Posterior pole view, 2228 x 1652 pixels.
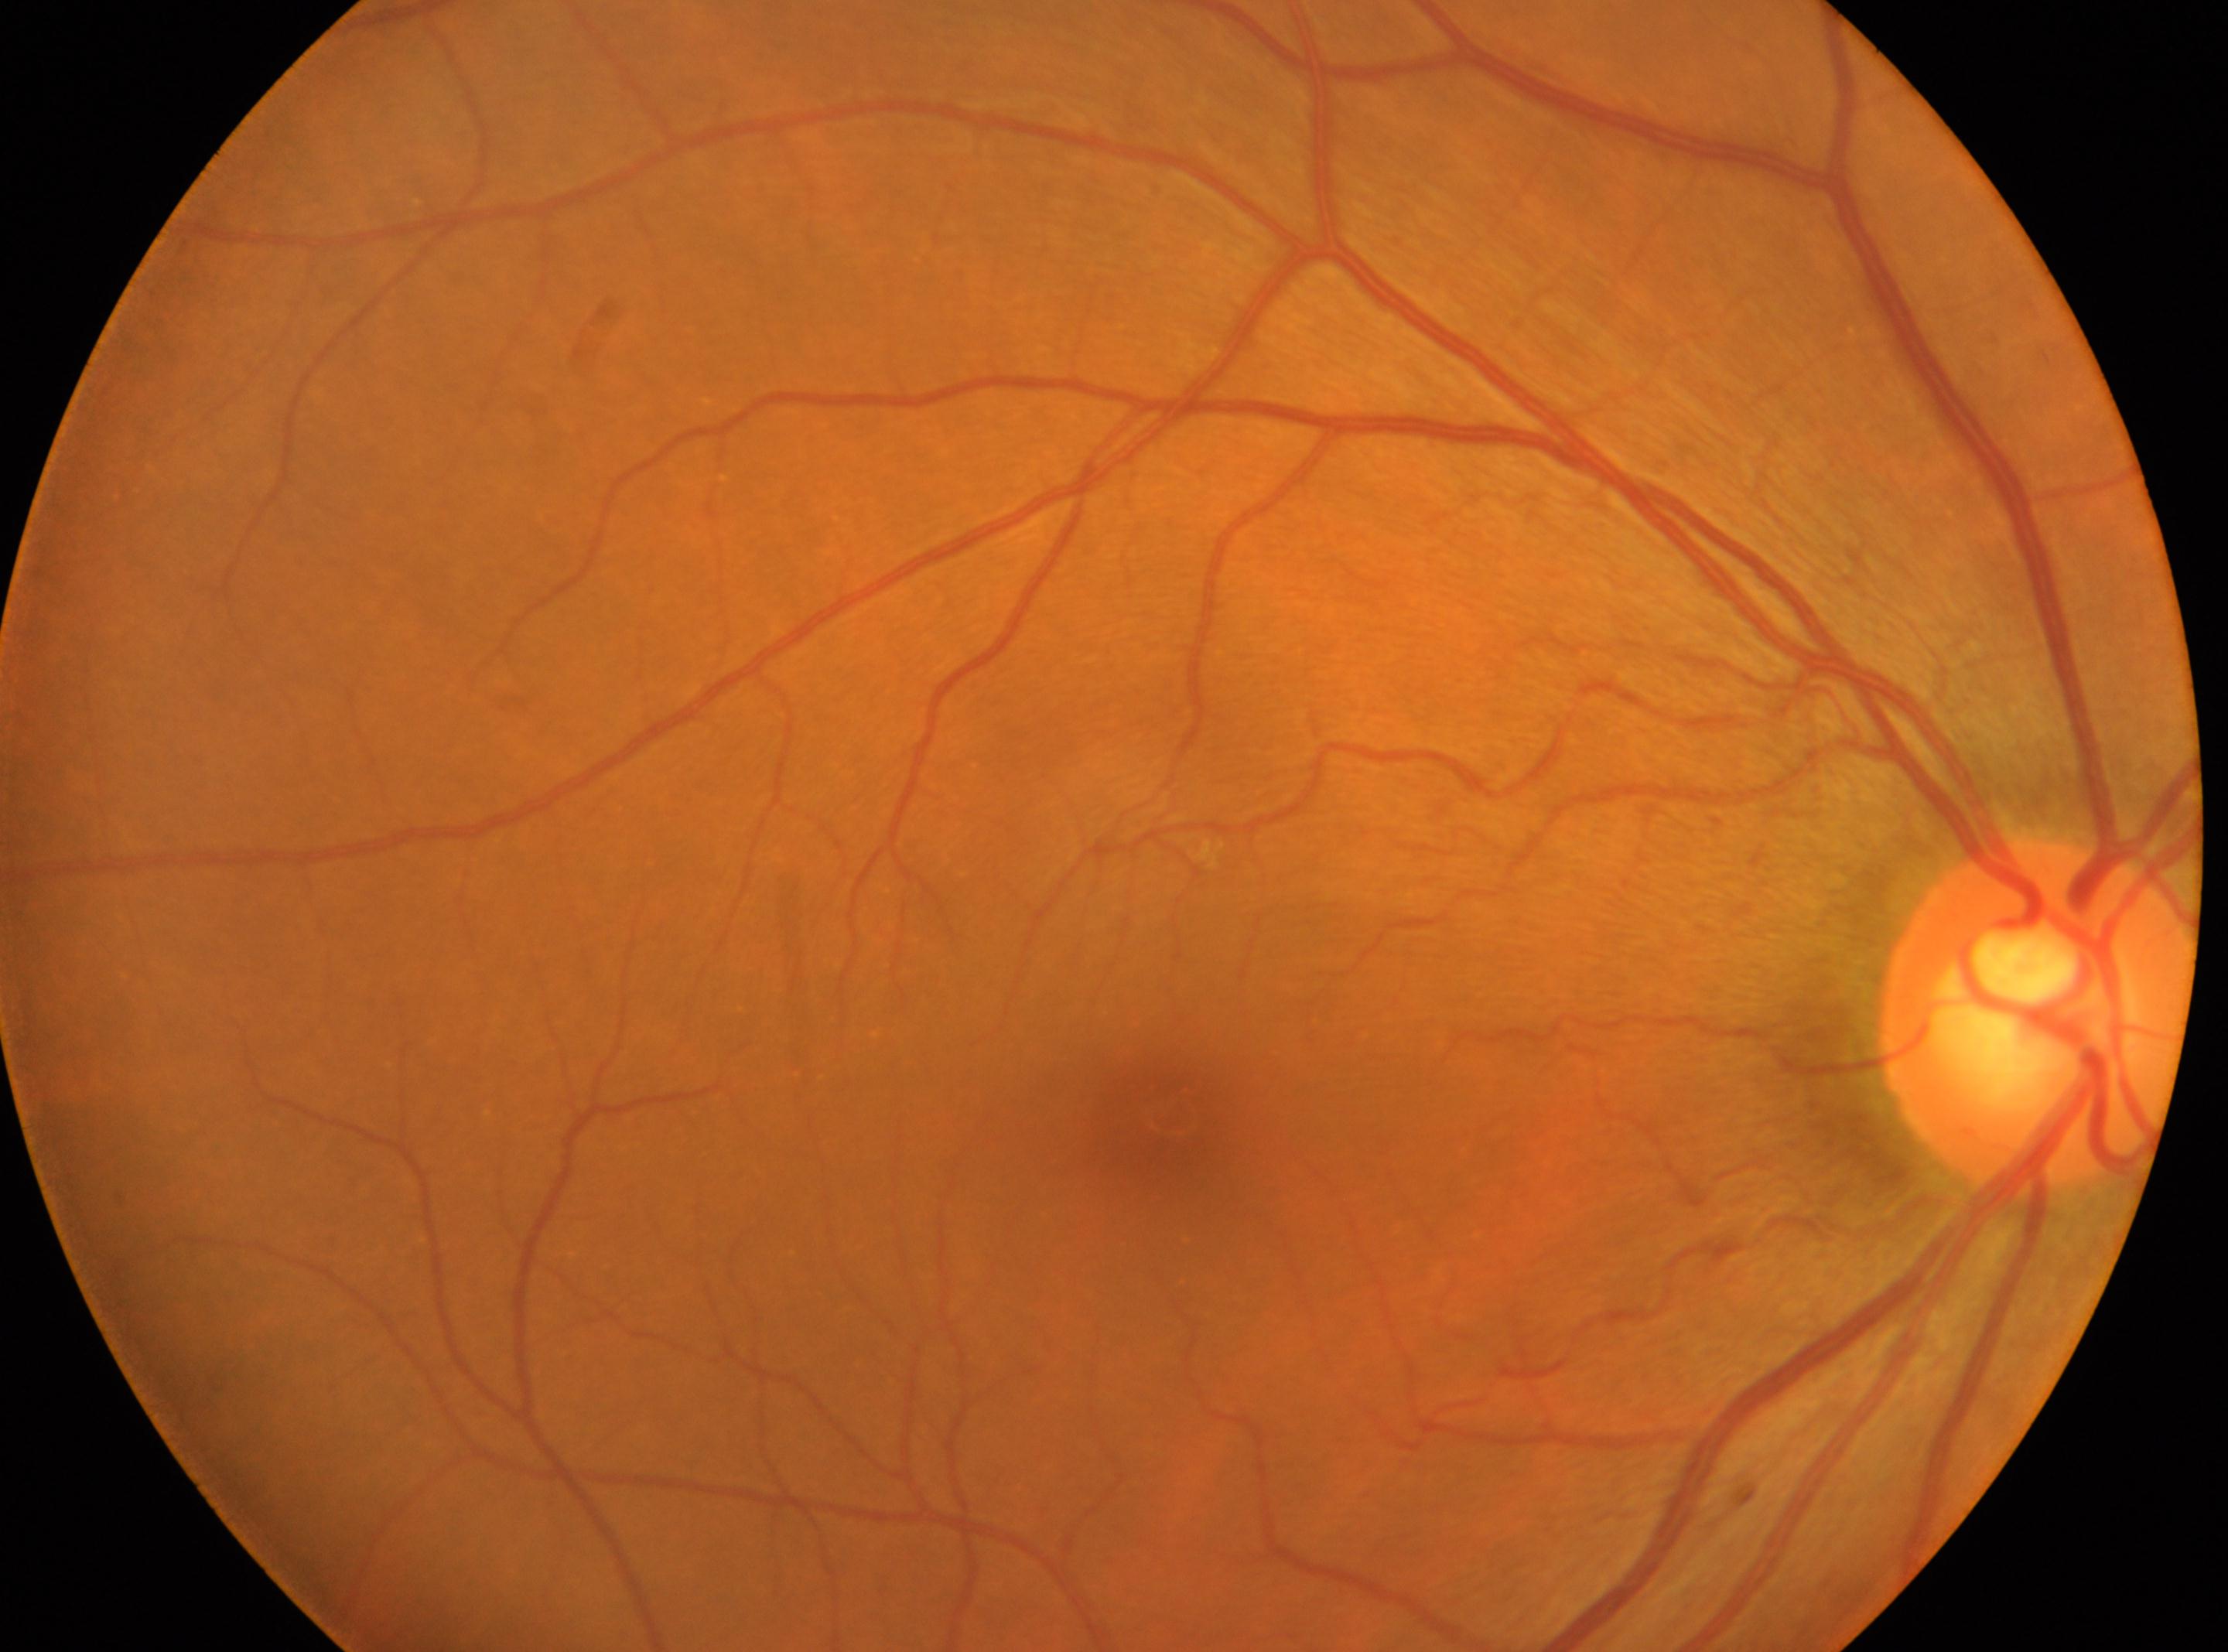 DR=grade 0 | macula center=1173px, 1115px | the right eye | optic disk=2037px, 1016px.